Retinal fundus photograph · FOV: 45 degrees · 2048x1536 — 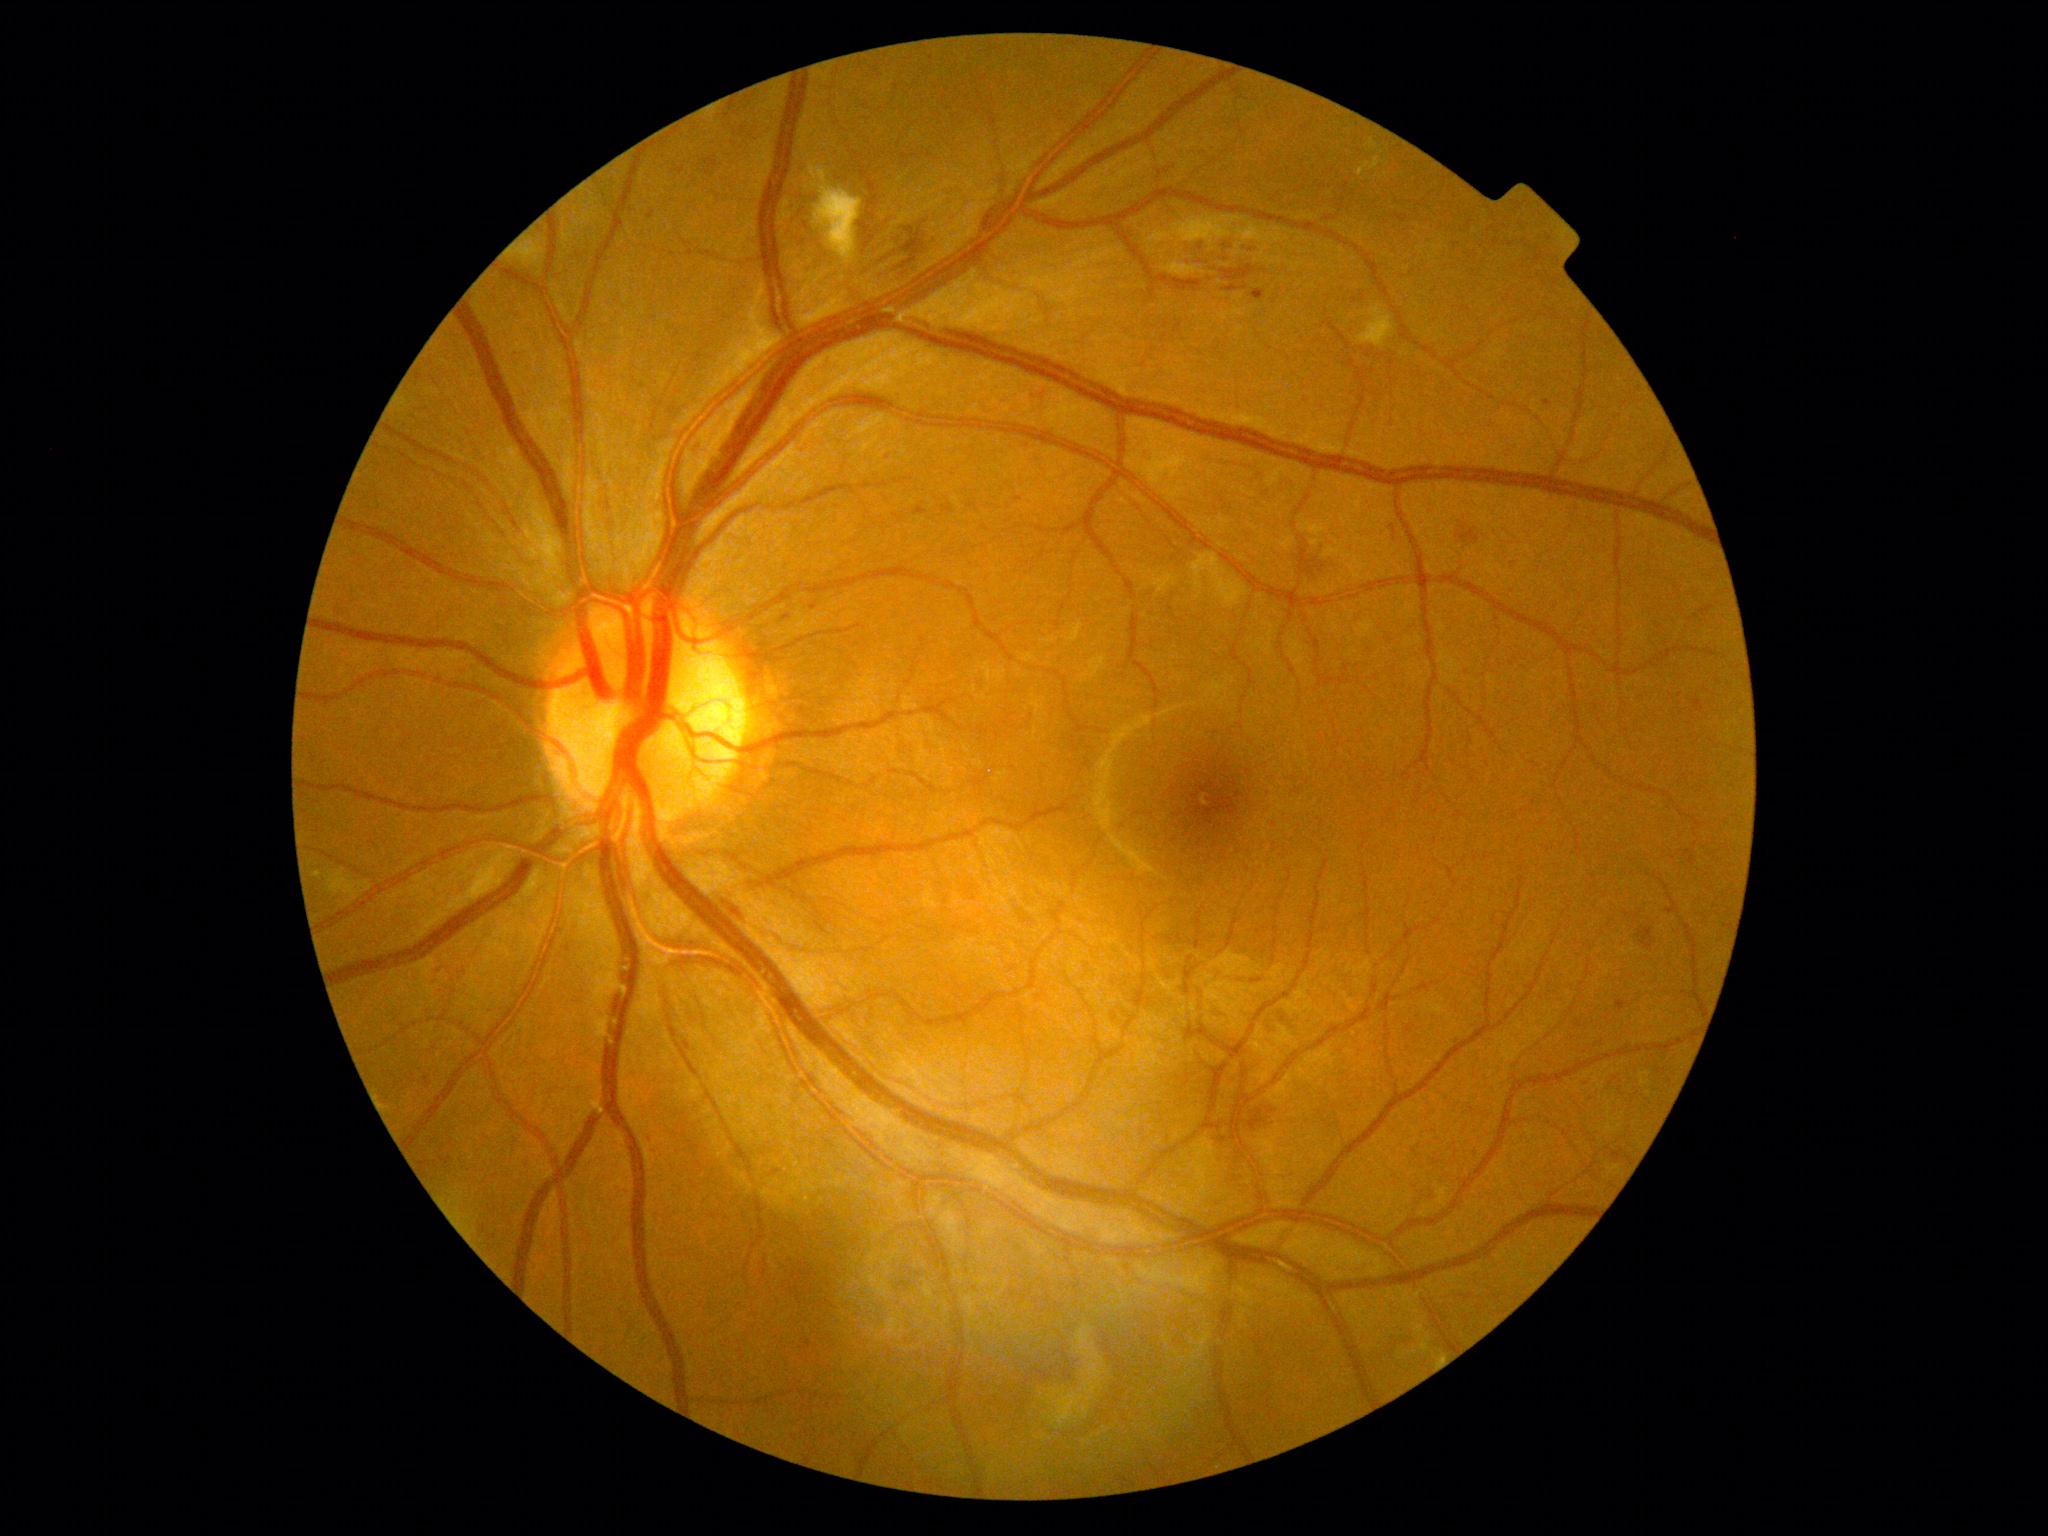
<lesions partial="true">
  <dr_grade>2</dr_grade>
  <ex>bbox=(1369, 157, 1380, 170), bbox=(1369, 139, 1377, 149), bbox=(1357, 163, 1370, 177)</ex>
  <he partial="true">bbox=(1224, 286, 1240, 293), bbox=(874, 246, 892, 262), bbox=(1638, 927, 1655, 951), bbox=(1307, 548, 1346, 578), bbox=(1220, 266, 1256, 282), bbox=(1216, 240, 1232, 250), bbox=(901, 228, 924, 270), bbox=(940, 504, 954, 514), bbox=(1390, 525, 1397, 535), bbox=(1243, 245, 1263, 255), bbox=(1249, 1109, 1266, 1132), bbox=(1194, 242, 1200, 252)</he>
  <he_small_centers>[1245,288]</he_small_centers>
  <se>bbox=(809, 165, 864, 265), bbox=(1163, 262, 1206, 278), bbox=(1357, 305, 1395, 348)</se>
  <ma>bbox=(777, 612, 792, 621), bbox=(1665, 908, 1674, 916), bbox=(894, 515, 905, 524), bbox=(1616, 1001, 1628, 1014), bbox=(807, 602, 814, 612), bbox=(1253, 290, 1266, 301), bbox=(432, 966, 445, 974), bbox=(425, 1077, 432, 1087)</ma>
  <ma_small_centers>[1018,500], [484,1229], [492,1238], [1456,245], [568,950], [1548,403], [1434,291], [887,458]</ma_small_centers>
</lesions>